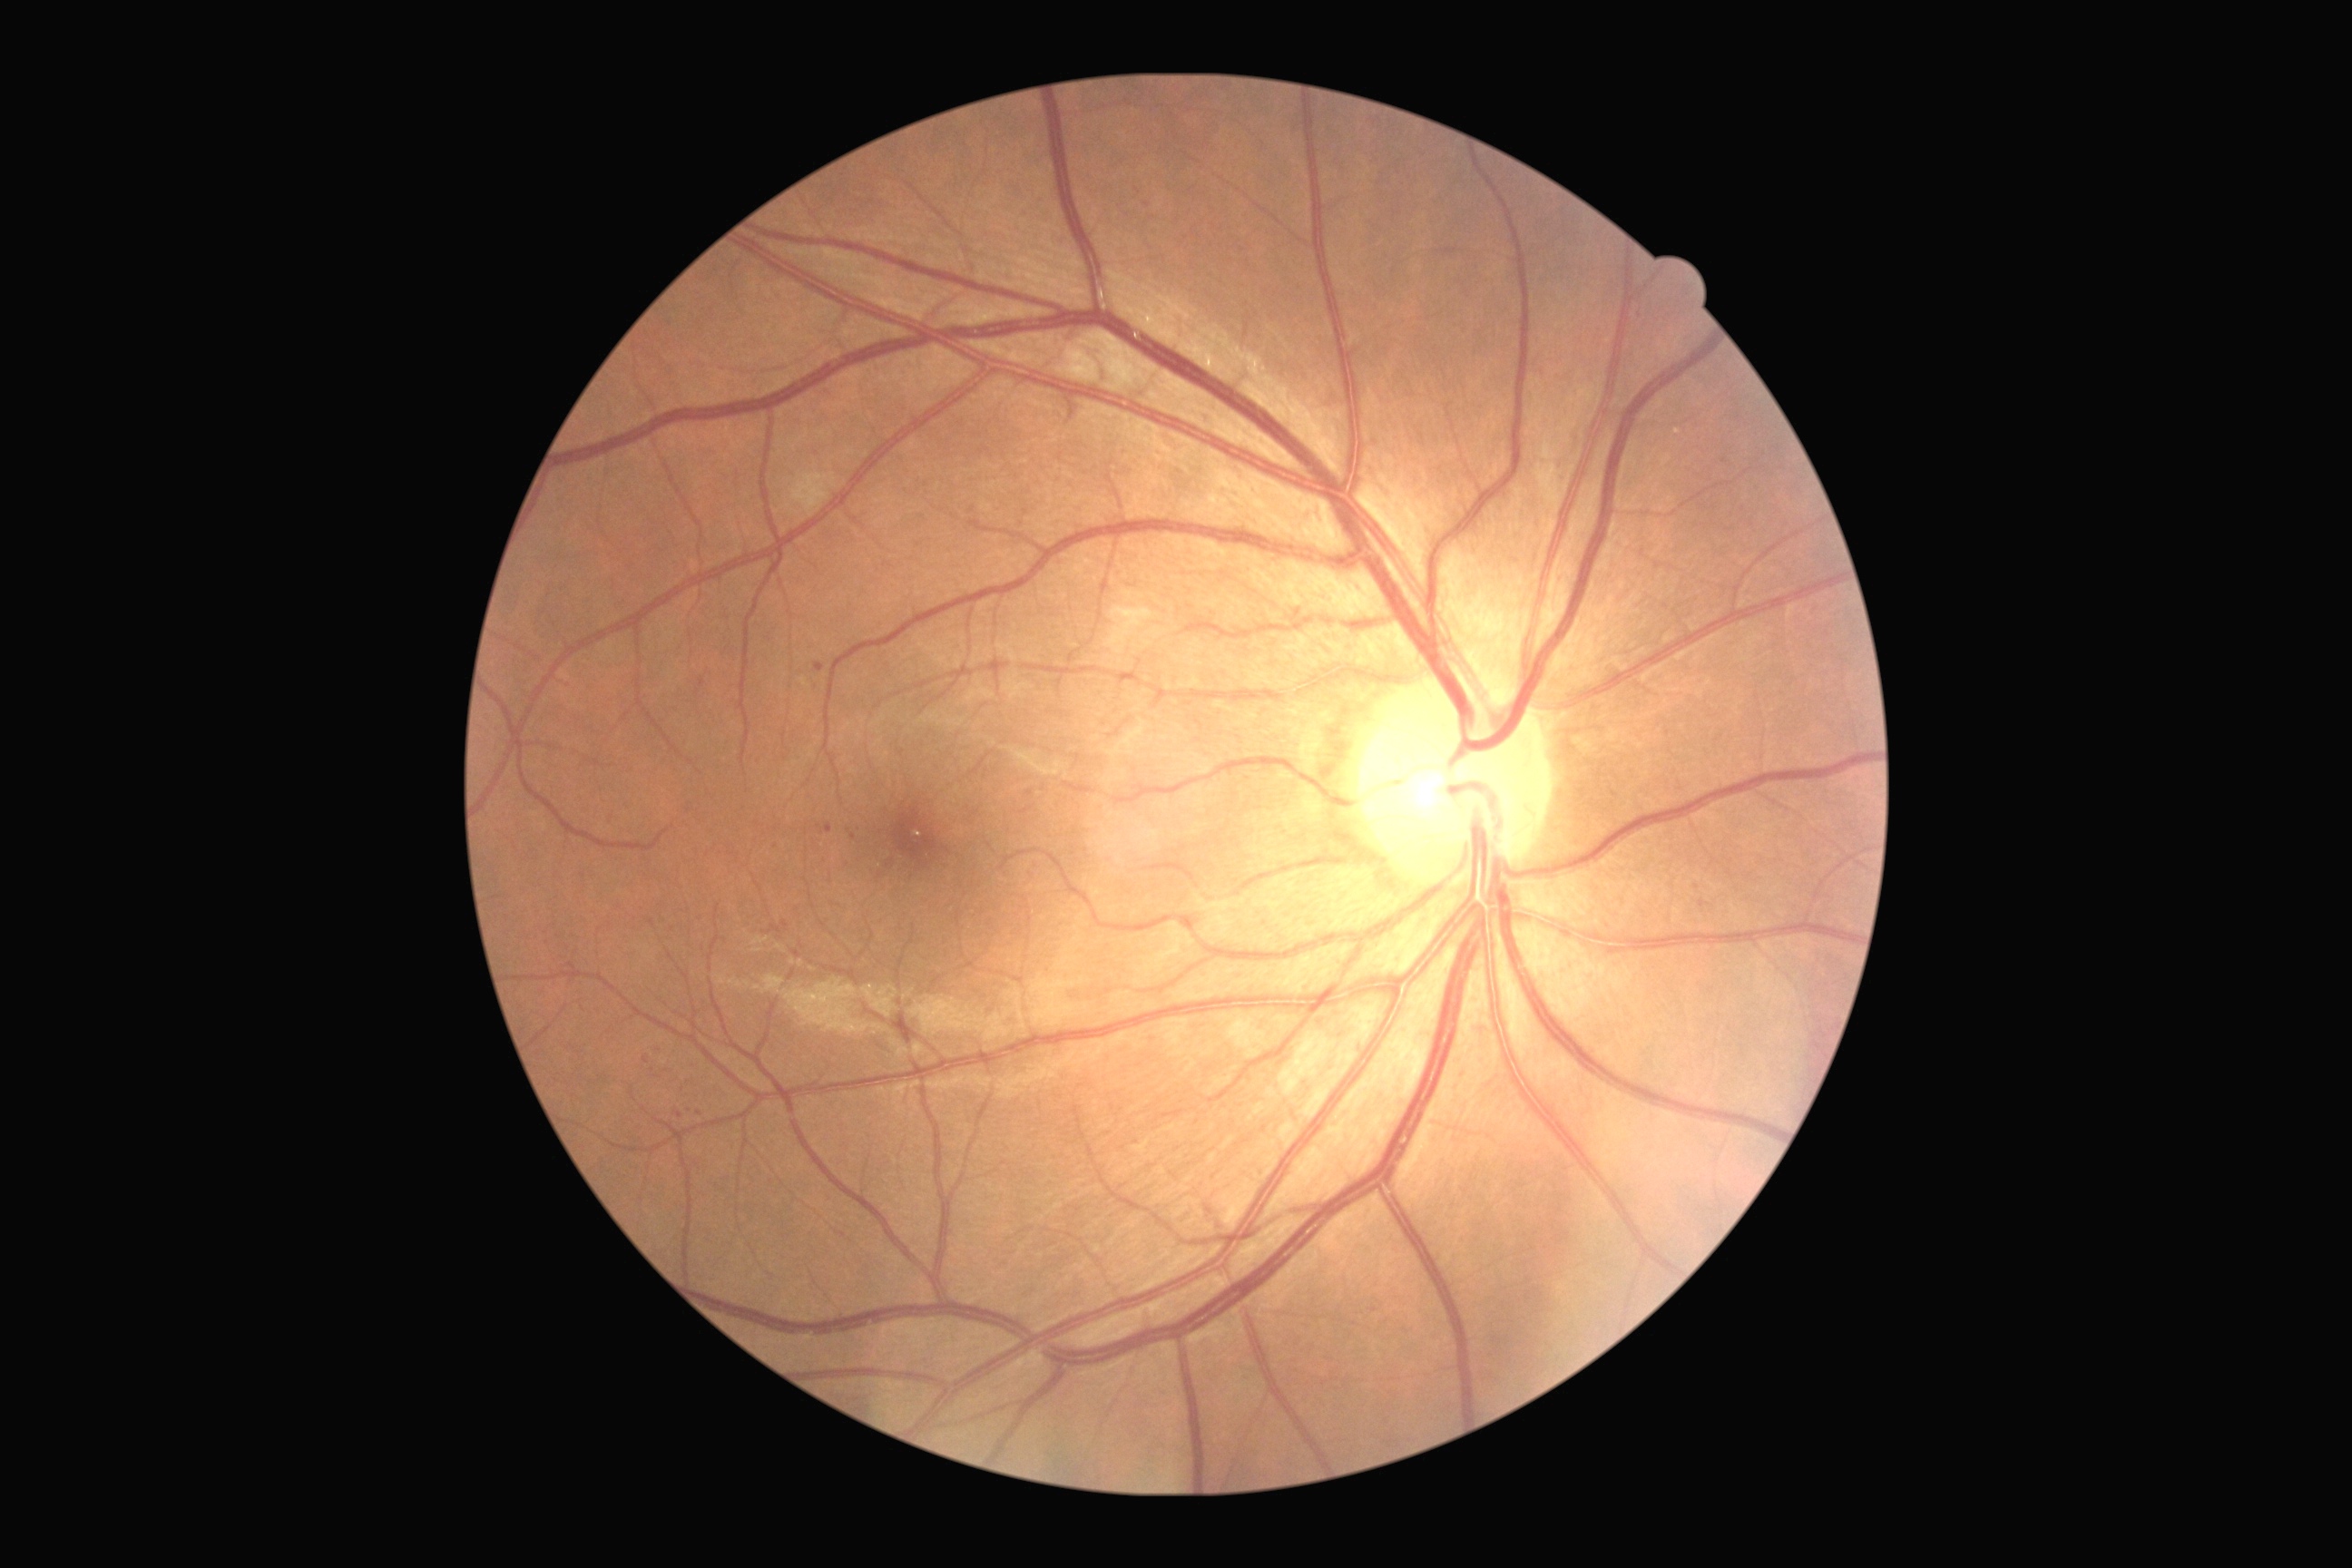
The retinopathy is classified as non-proliferative diabetic retinopathy.
DR stage: grade 2 — more than just microaneurysms but less than severe NPDR.